Acquired with a NIDEK AFC-230. Image size 848x848. Modified Davis classification: 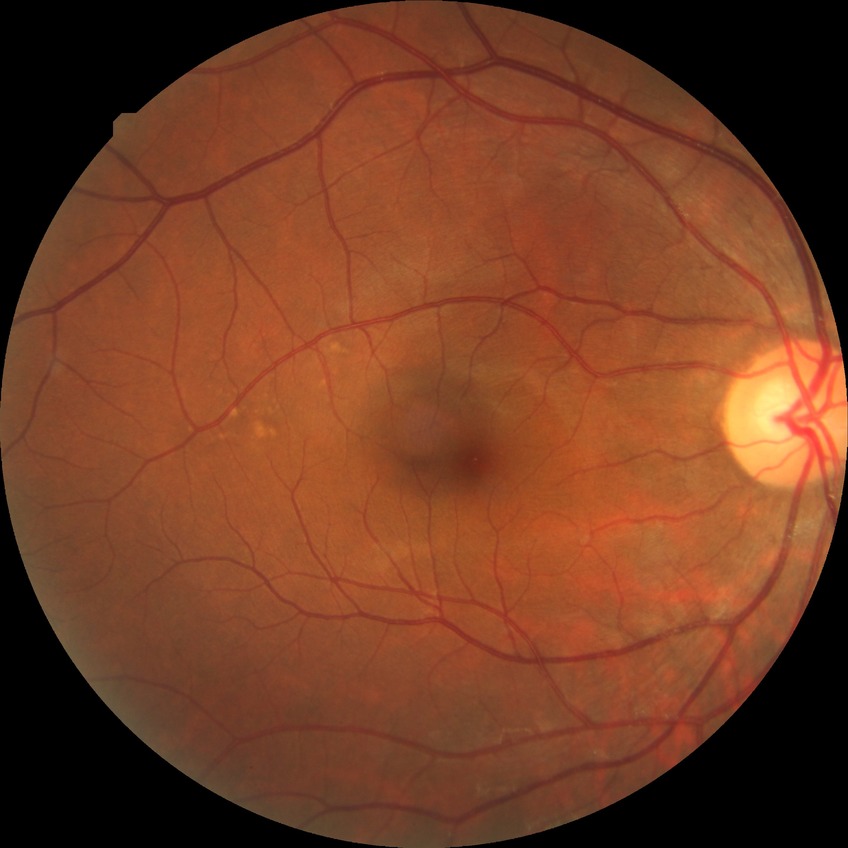
diabetic retinopathy (DR) = no diabetic retinopathy (NDR)